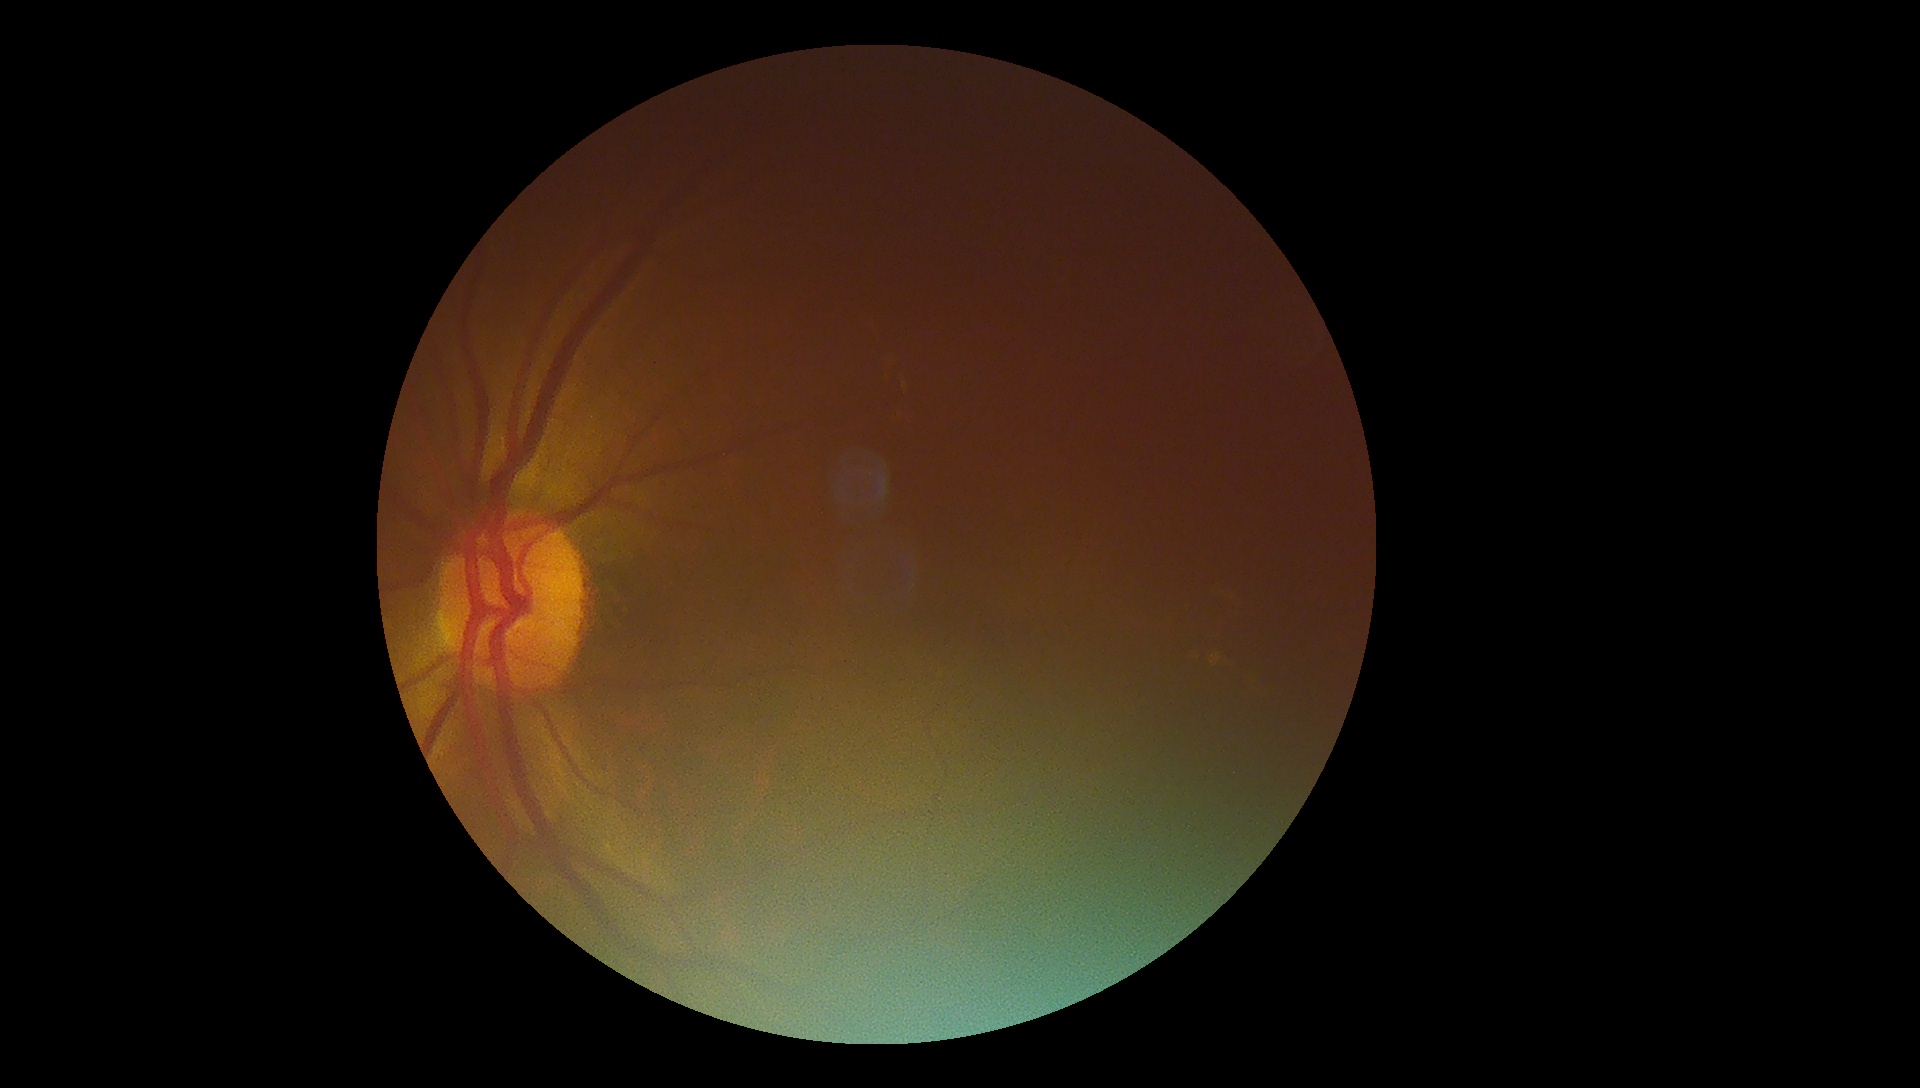 – DR class: non-proliferative diabetic retinopathy
– DR: moderate non-proliferative diabetic retinopathy (grade 2)